CFP, diabetic retinopathy graded by the modified Davis classification, acquired with a NIDEK AFC-230: 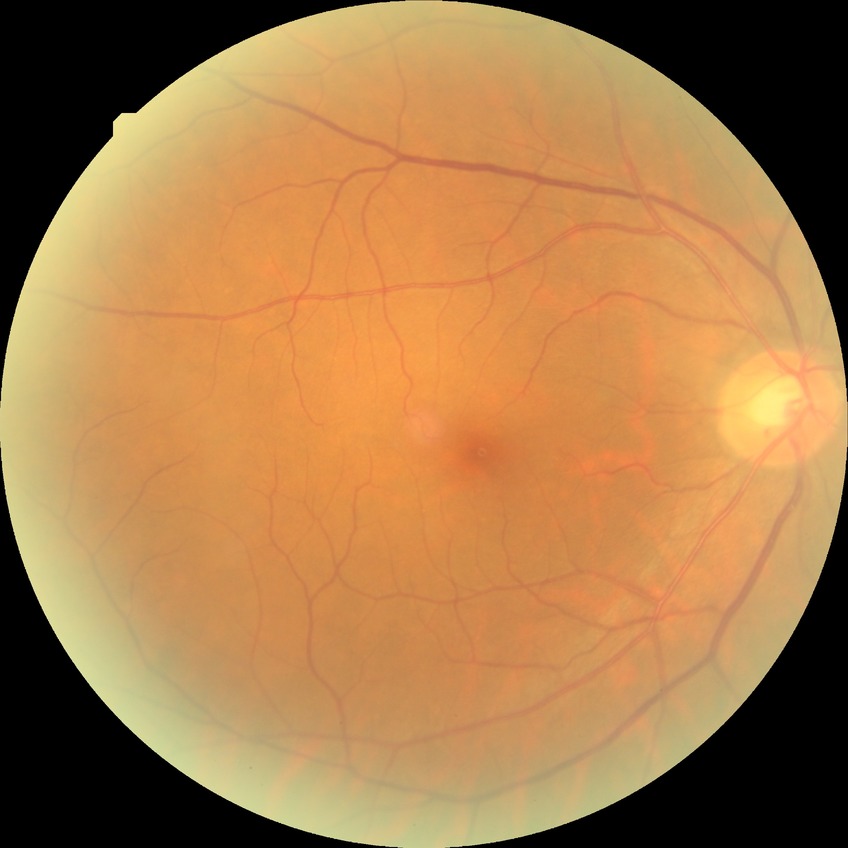

retinopathy grade = no diabetic retinopathy.